FOV: 45 degrees.
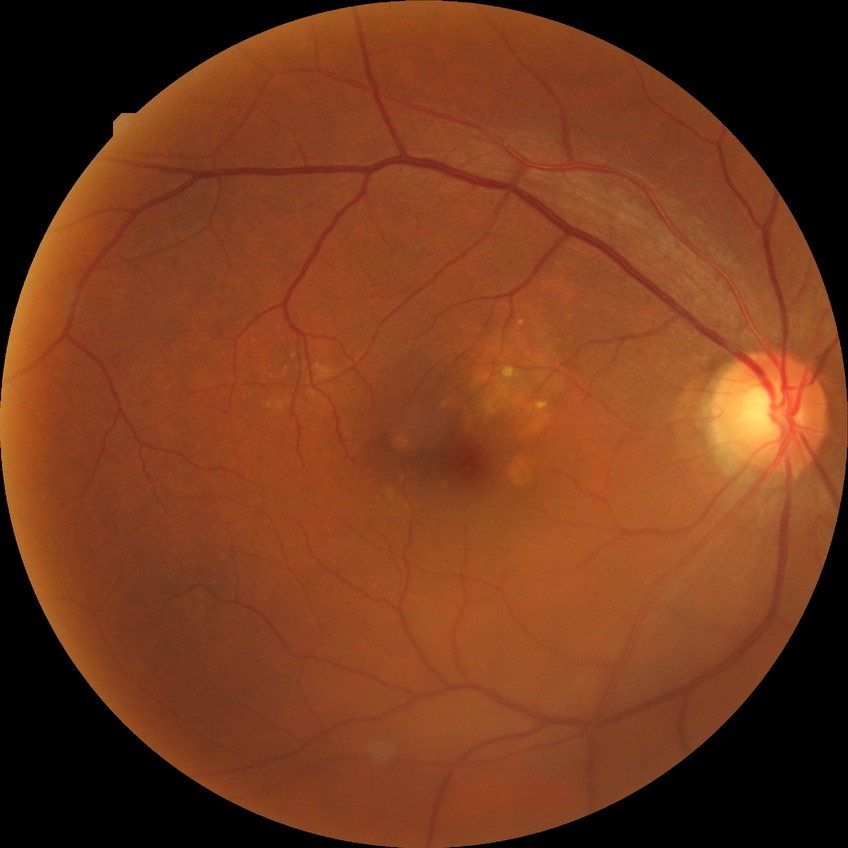 {"davis_grade": "no diabetic retinopathy (NDR)"}